Fundus photo · FOV: 45 degrees · 2212 x 1659 pixels
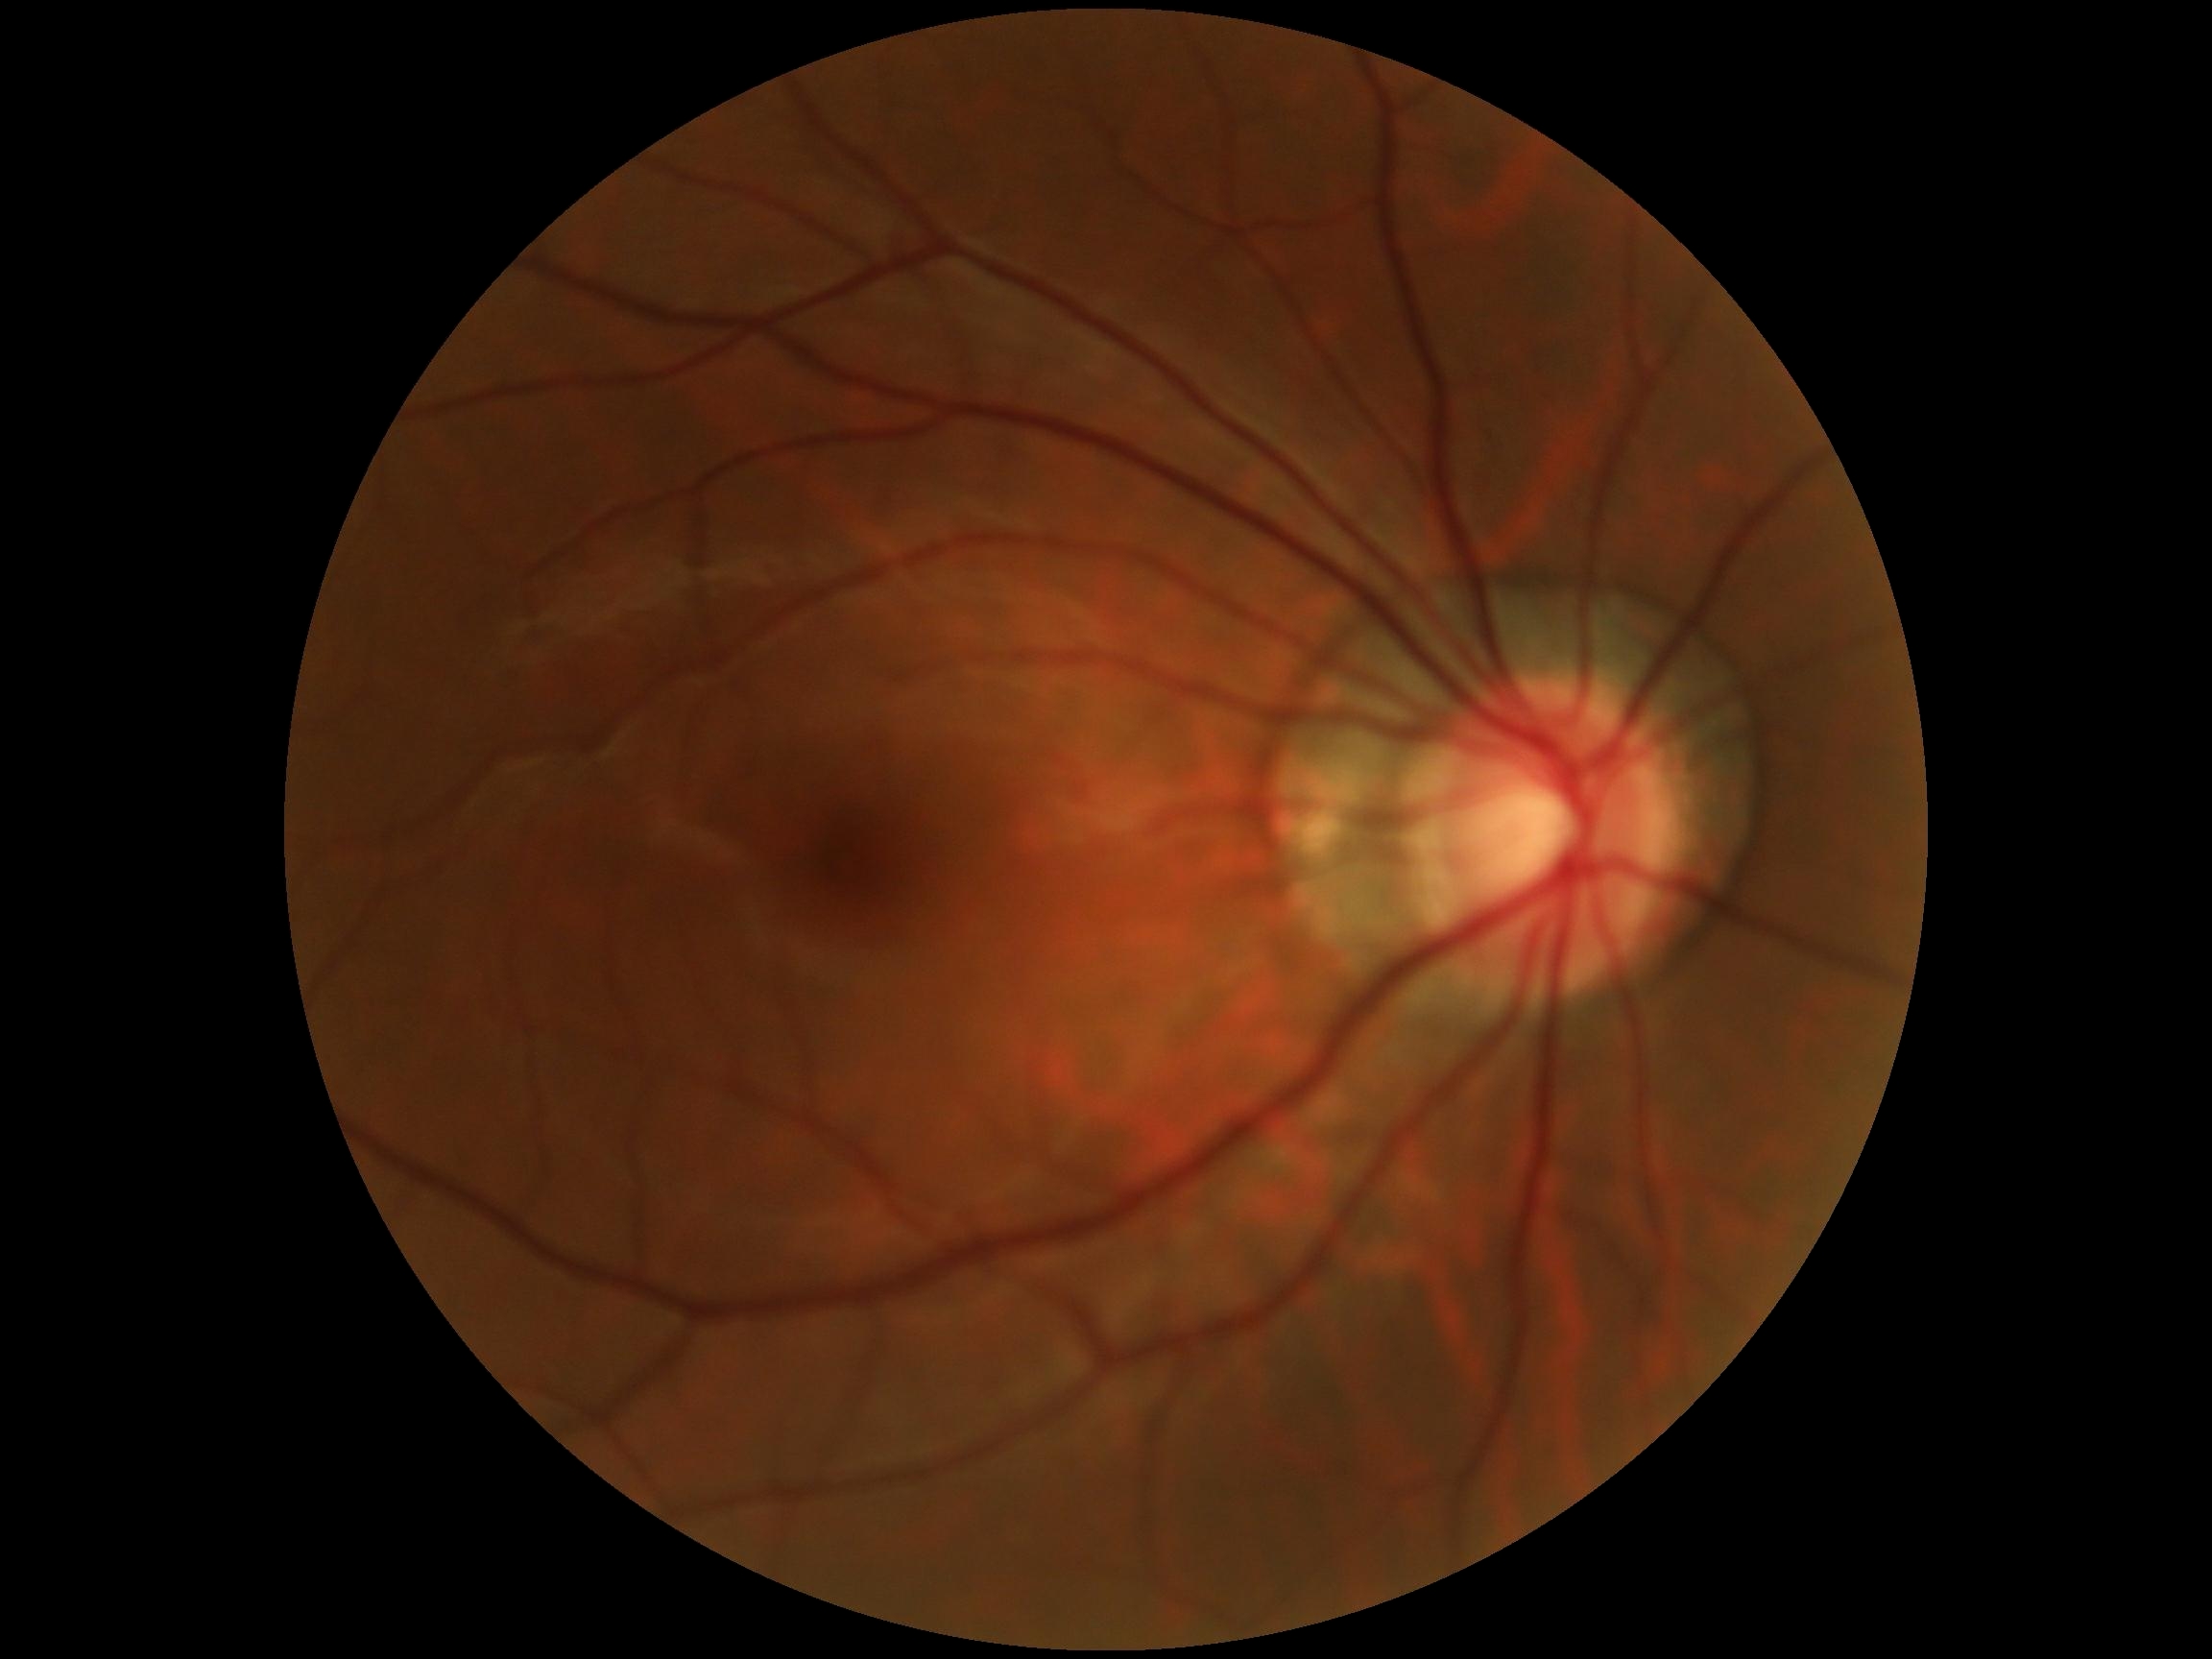 DR stage: 0/4.